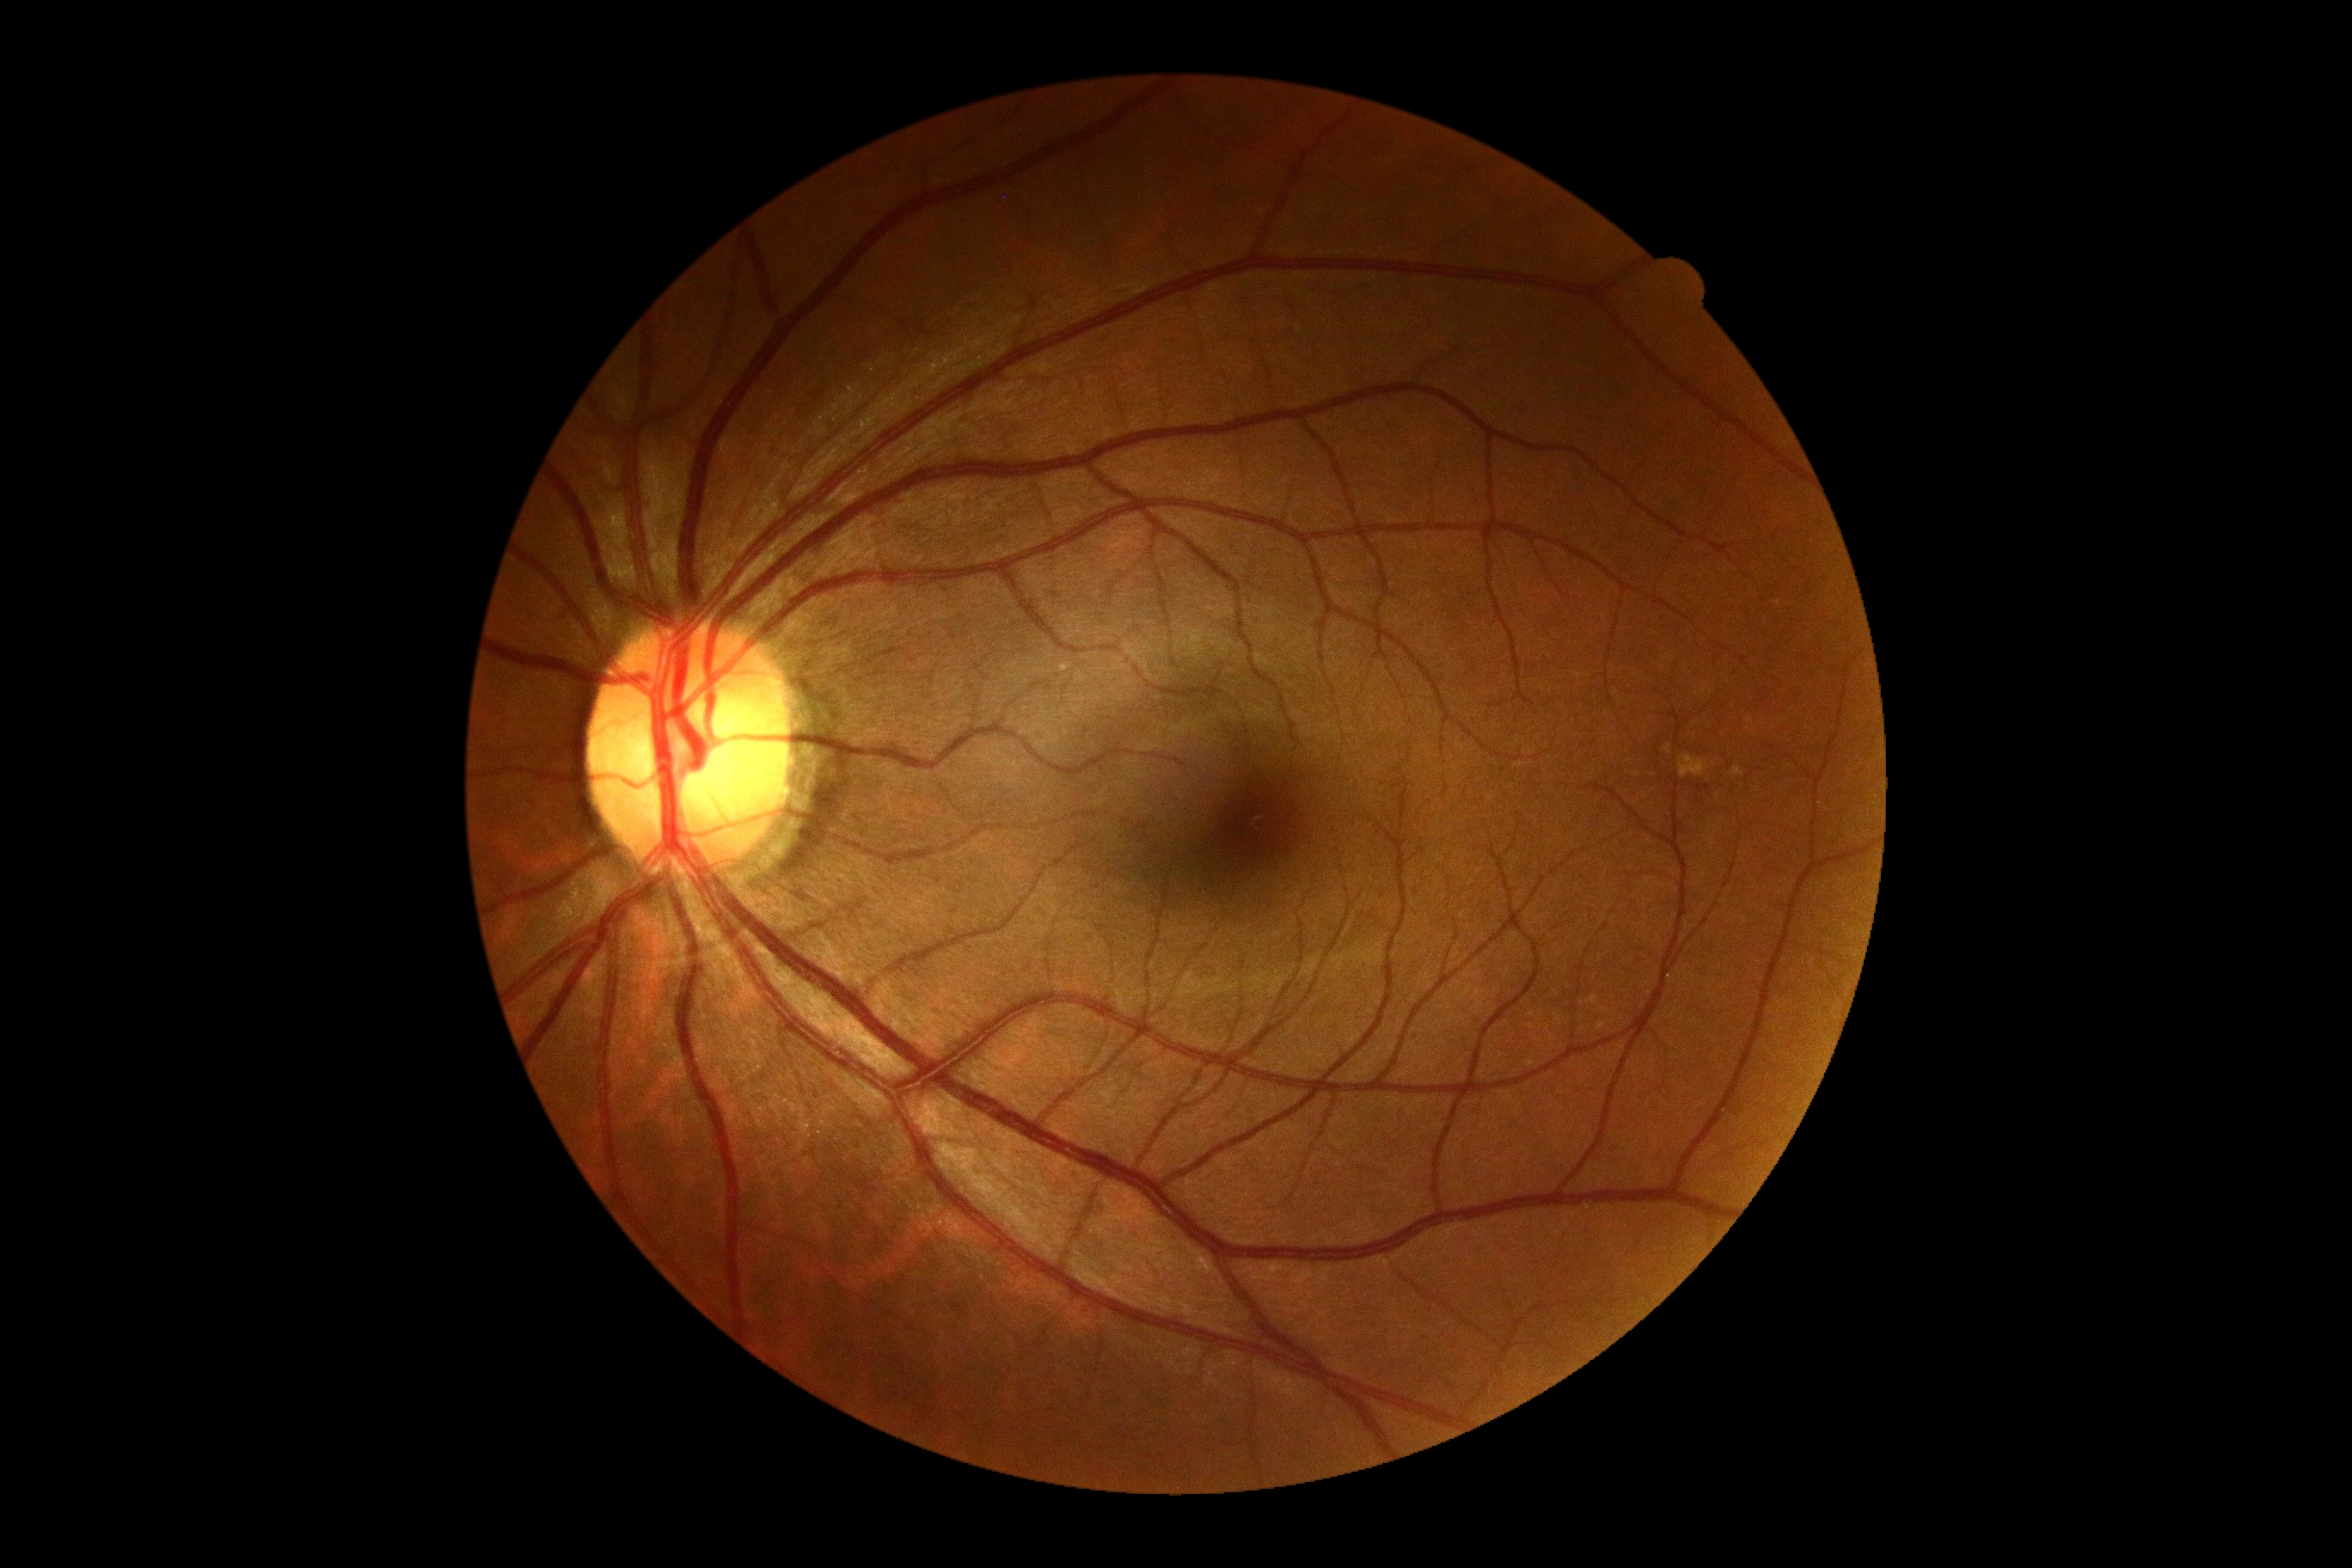
No signs of diabetic retinopathy.
Retinopathy grade is no apparent diabetic retinopathy (0).